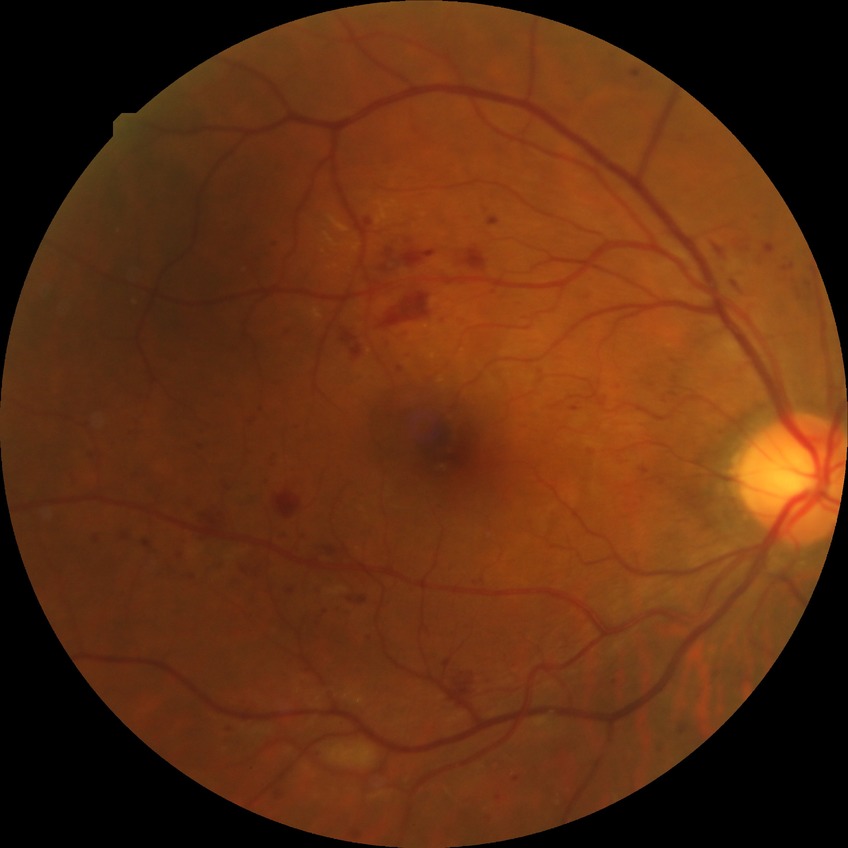

{"davis_grade": "pre-proliferative diabetic retinopathy", "proliferative_class": "non-proliferative diabetic retinopathy"}